Color fundus photograph.
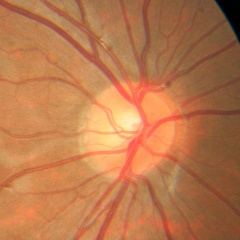 No glaucomatous findings.